CFP, 45-degree field of view
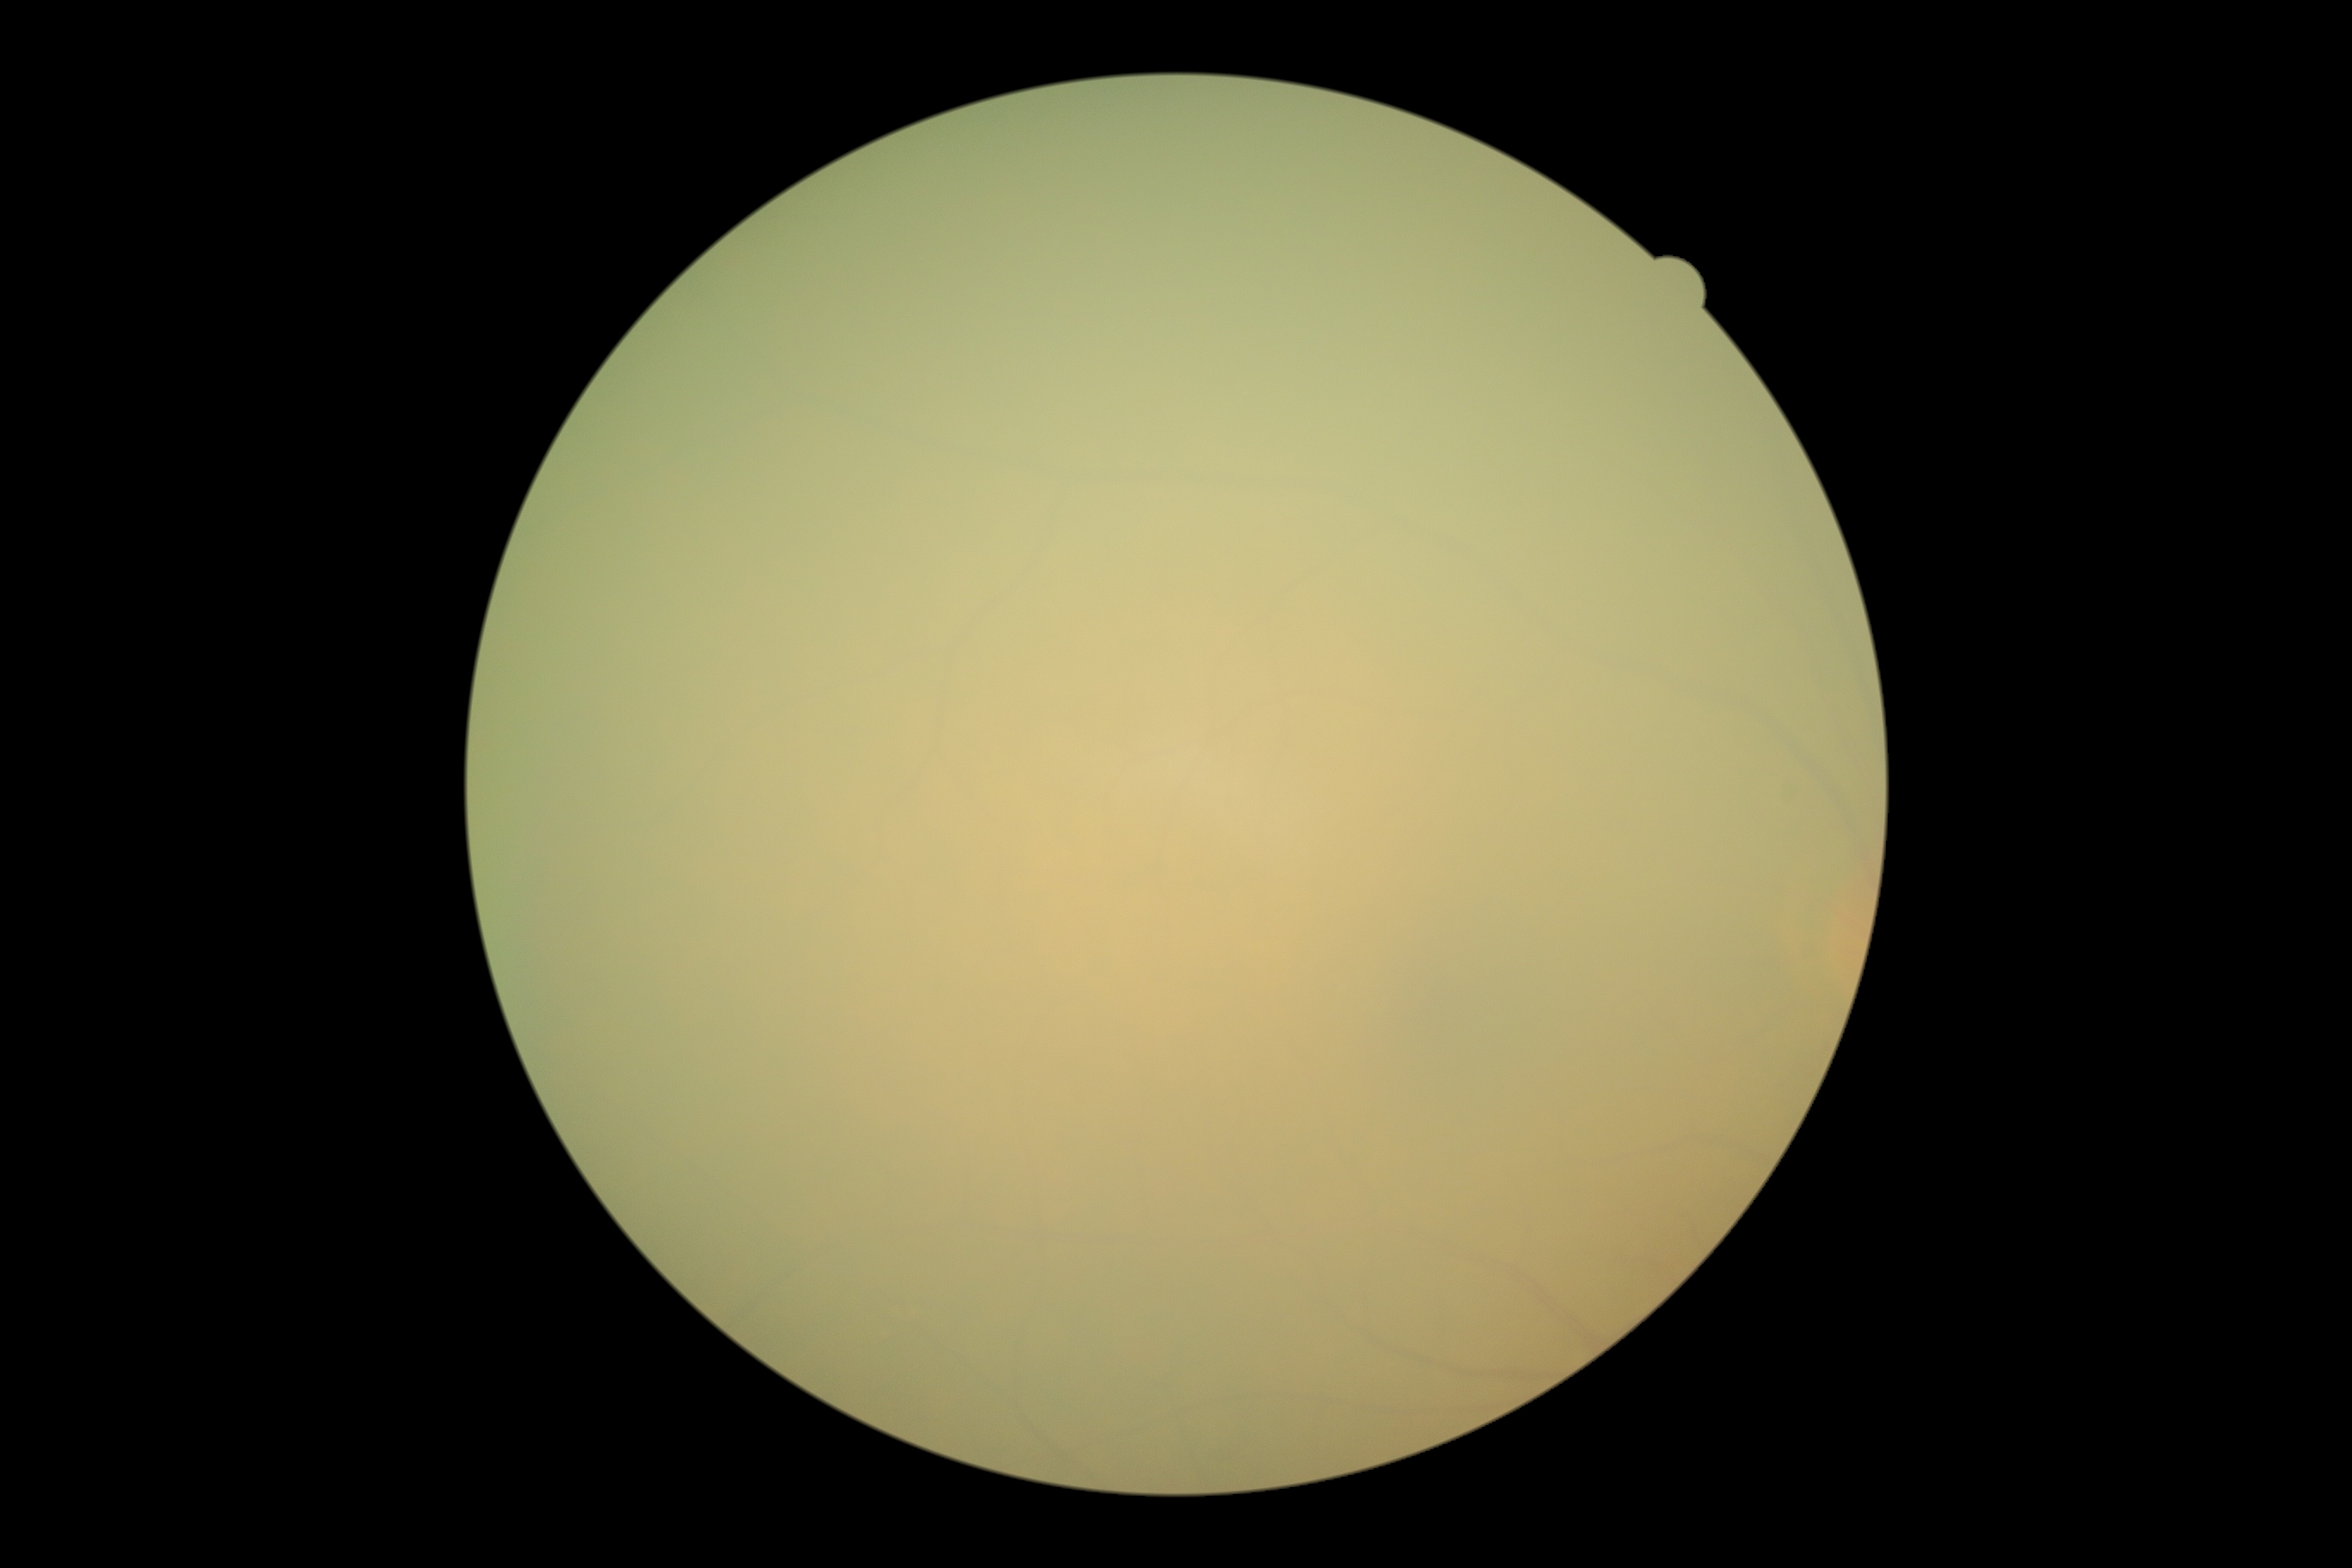

* image quality — insufficient for DR assessment
* diabetic retinopathy grade — ungradable due to poor image quality